848 by 848 pixels; acquired with a NIDEK AFC-230.
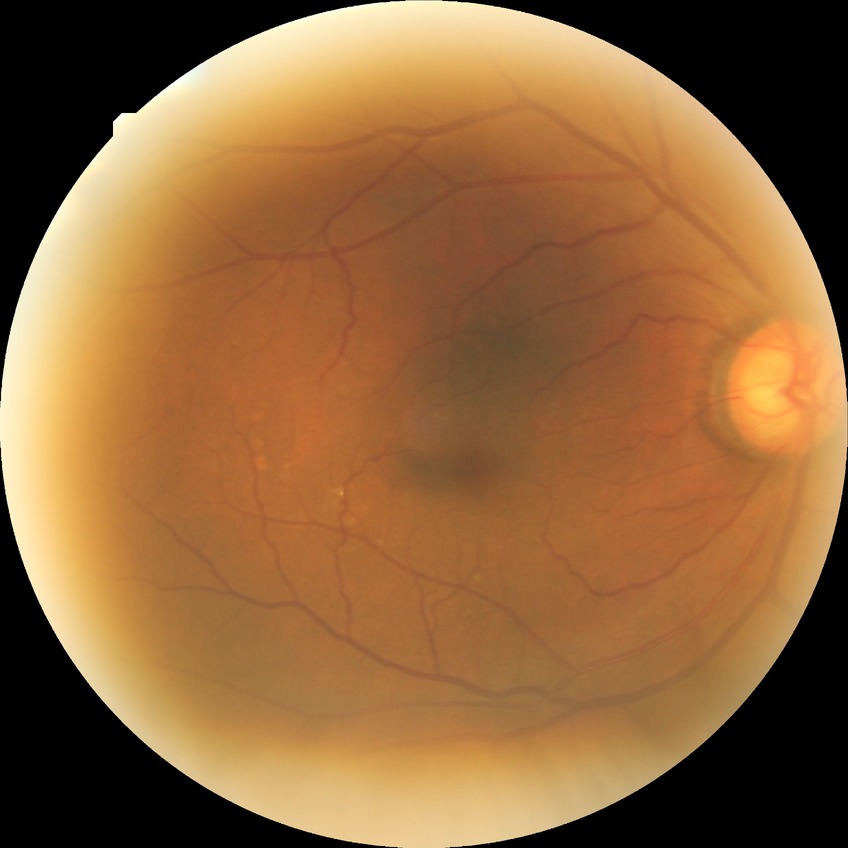
DR: NDR. No signs of diabetic retinopathy.